Acquired on the Natus RetCam Envision; wide-field fundus photograph of an infant; 1440x1080:
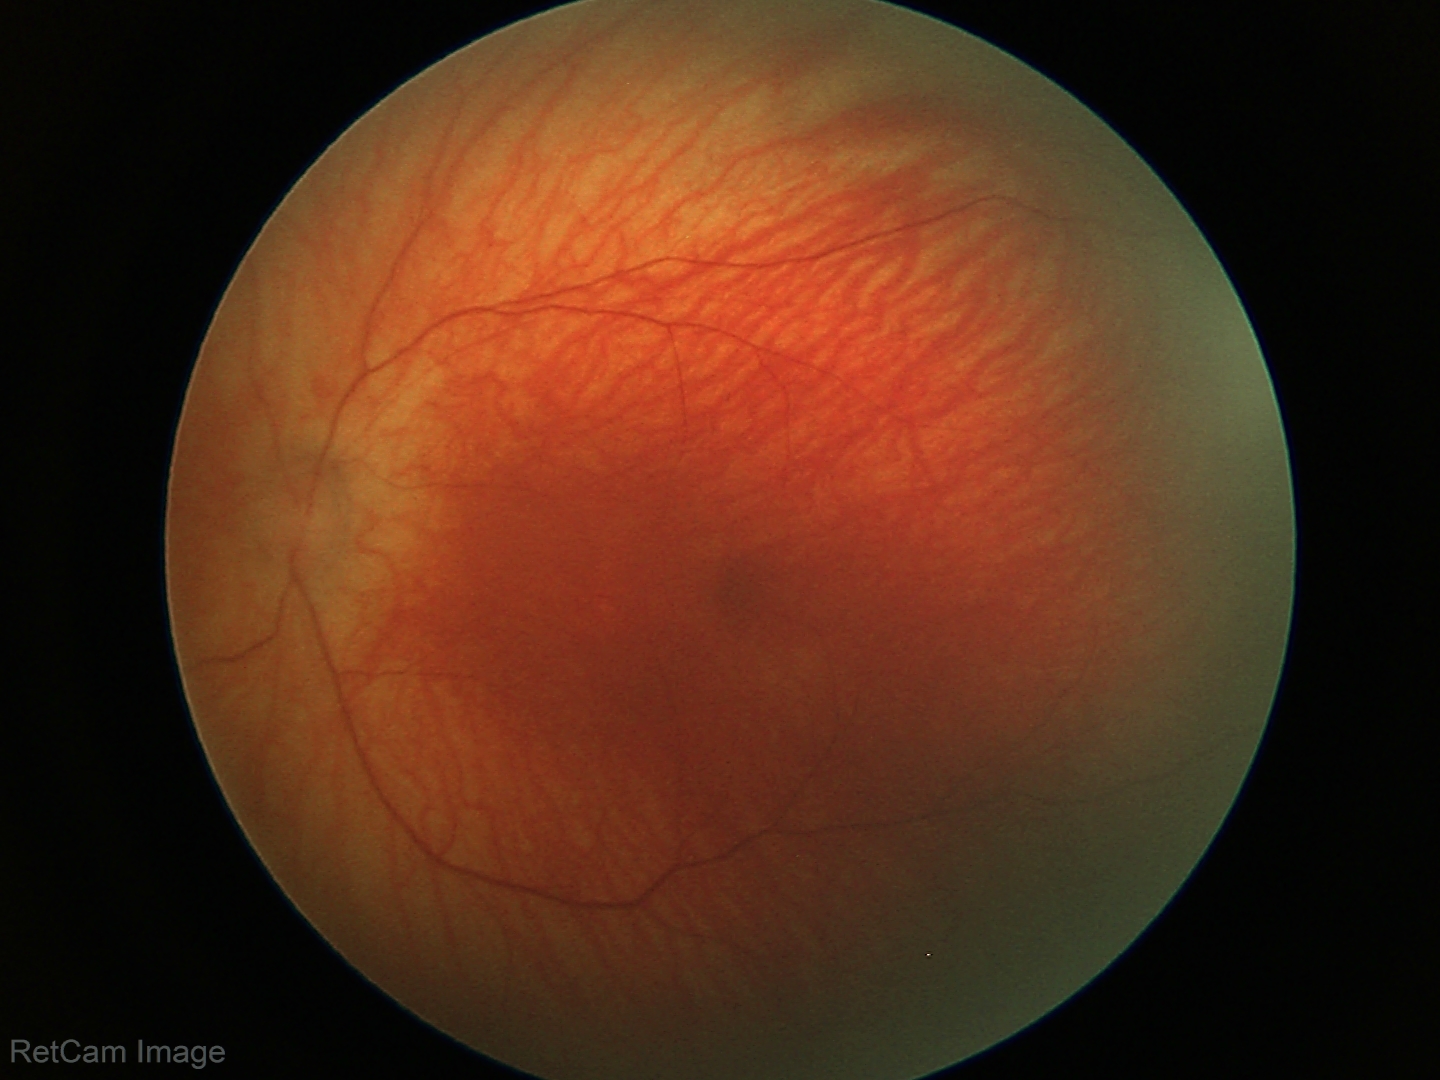 Physiological retinal appearance for postconceptual age.